Davis DR grading · 848x848 · retinal fundus photograph · NIDEK AFC-230 · no pharmacologic dilation · 45 degree fundus photograph:
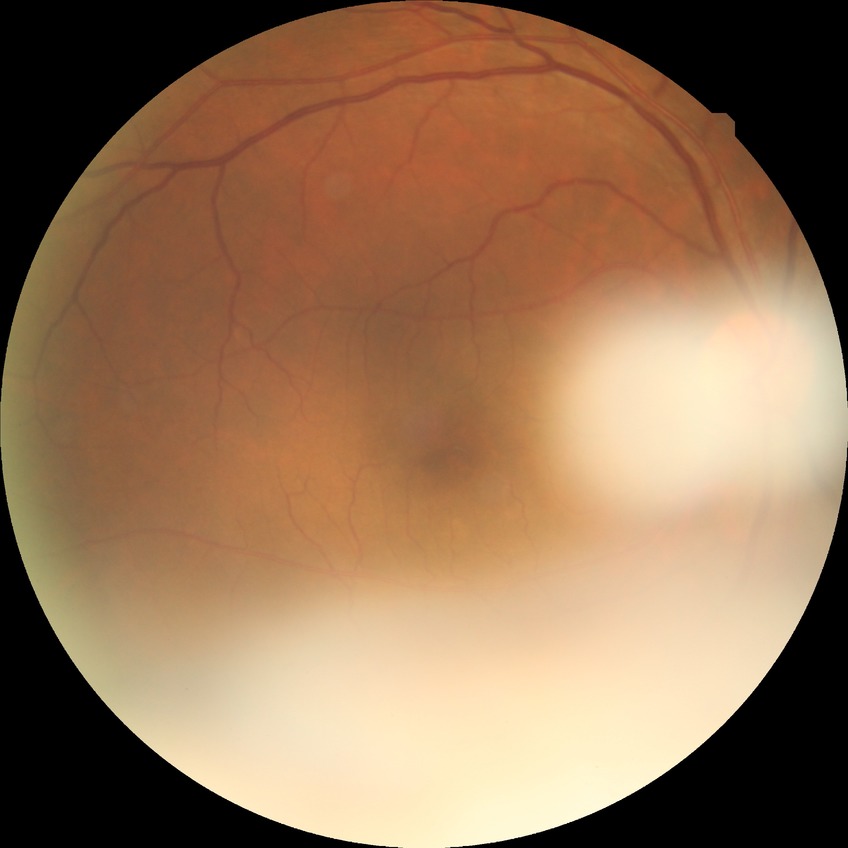 {
  "davis_grade": "no diabetic retinopathy"
}